Color fundus image, FOV: 45 degrees — 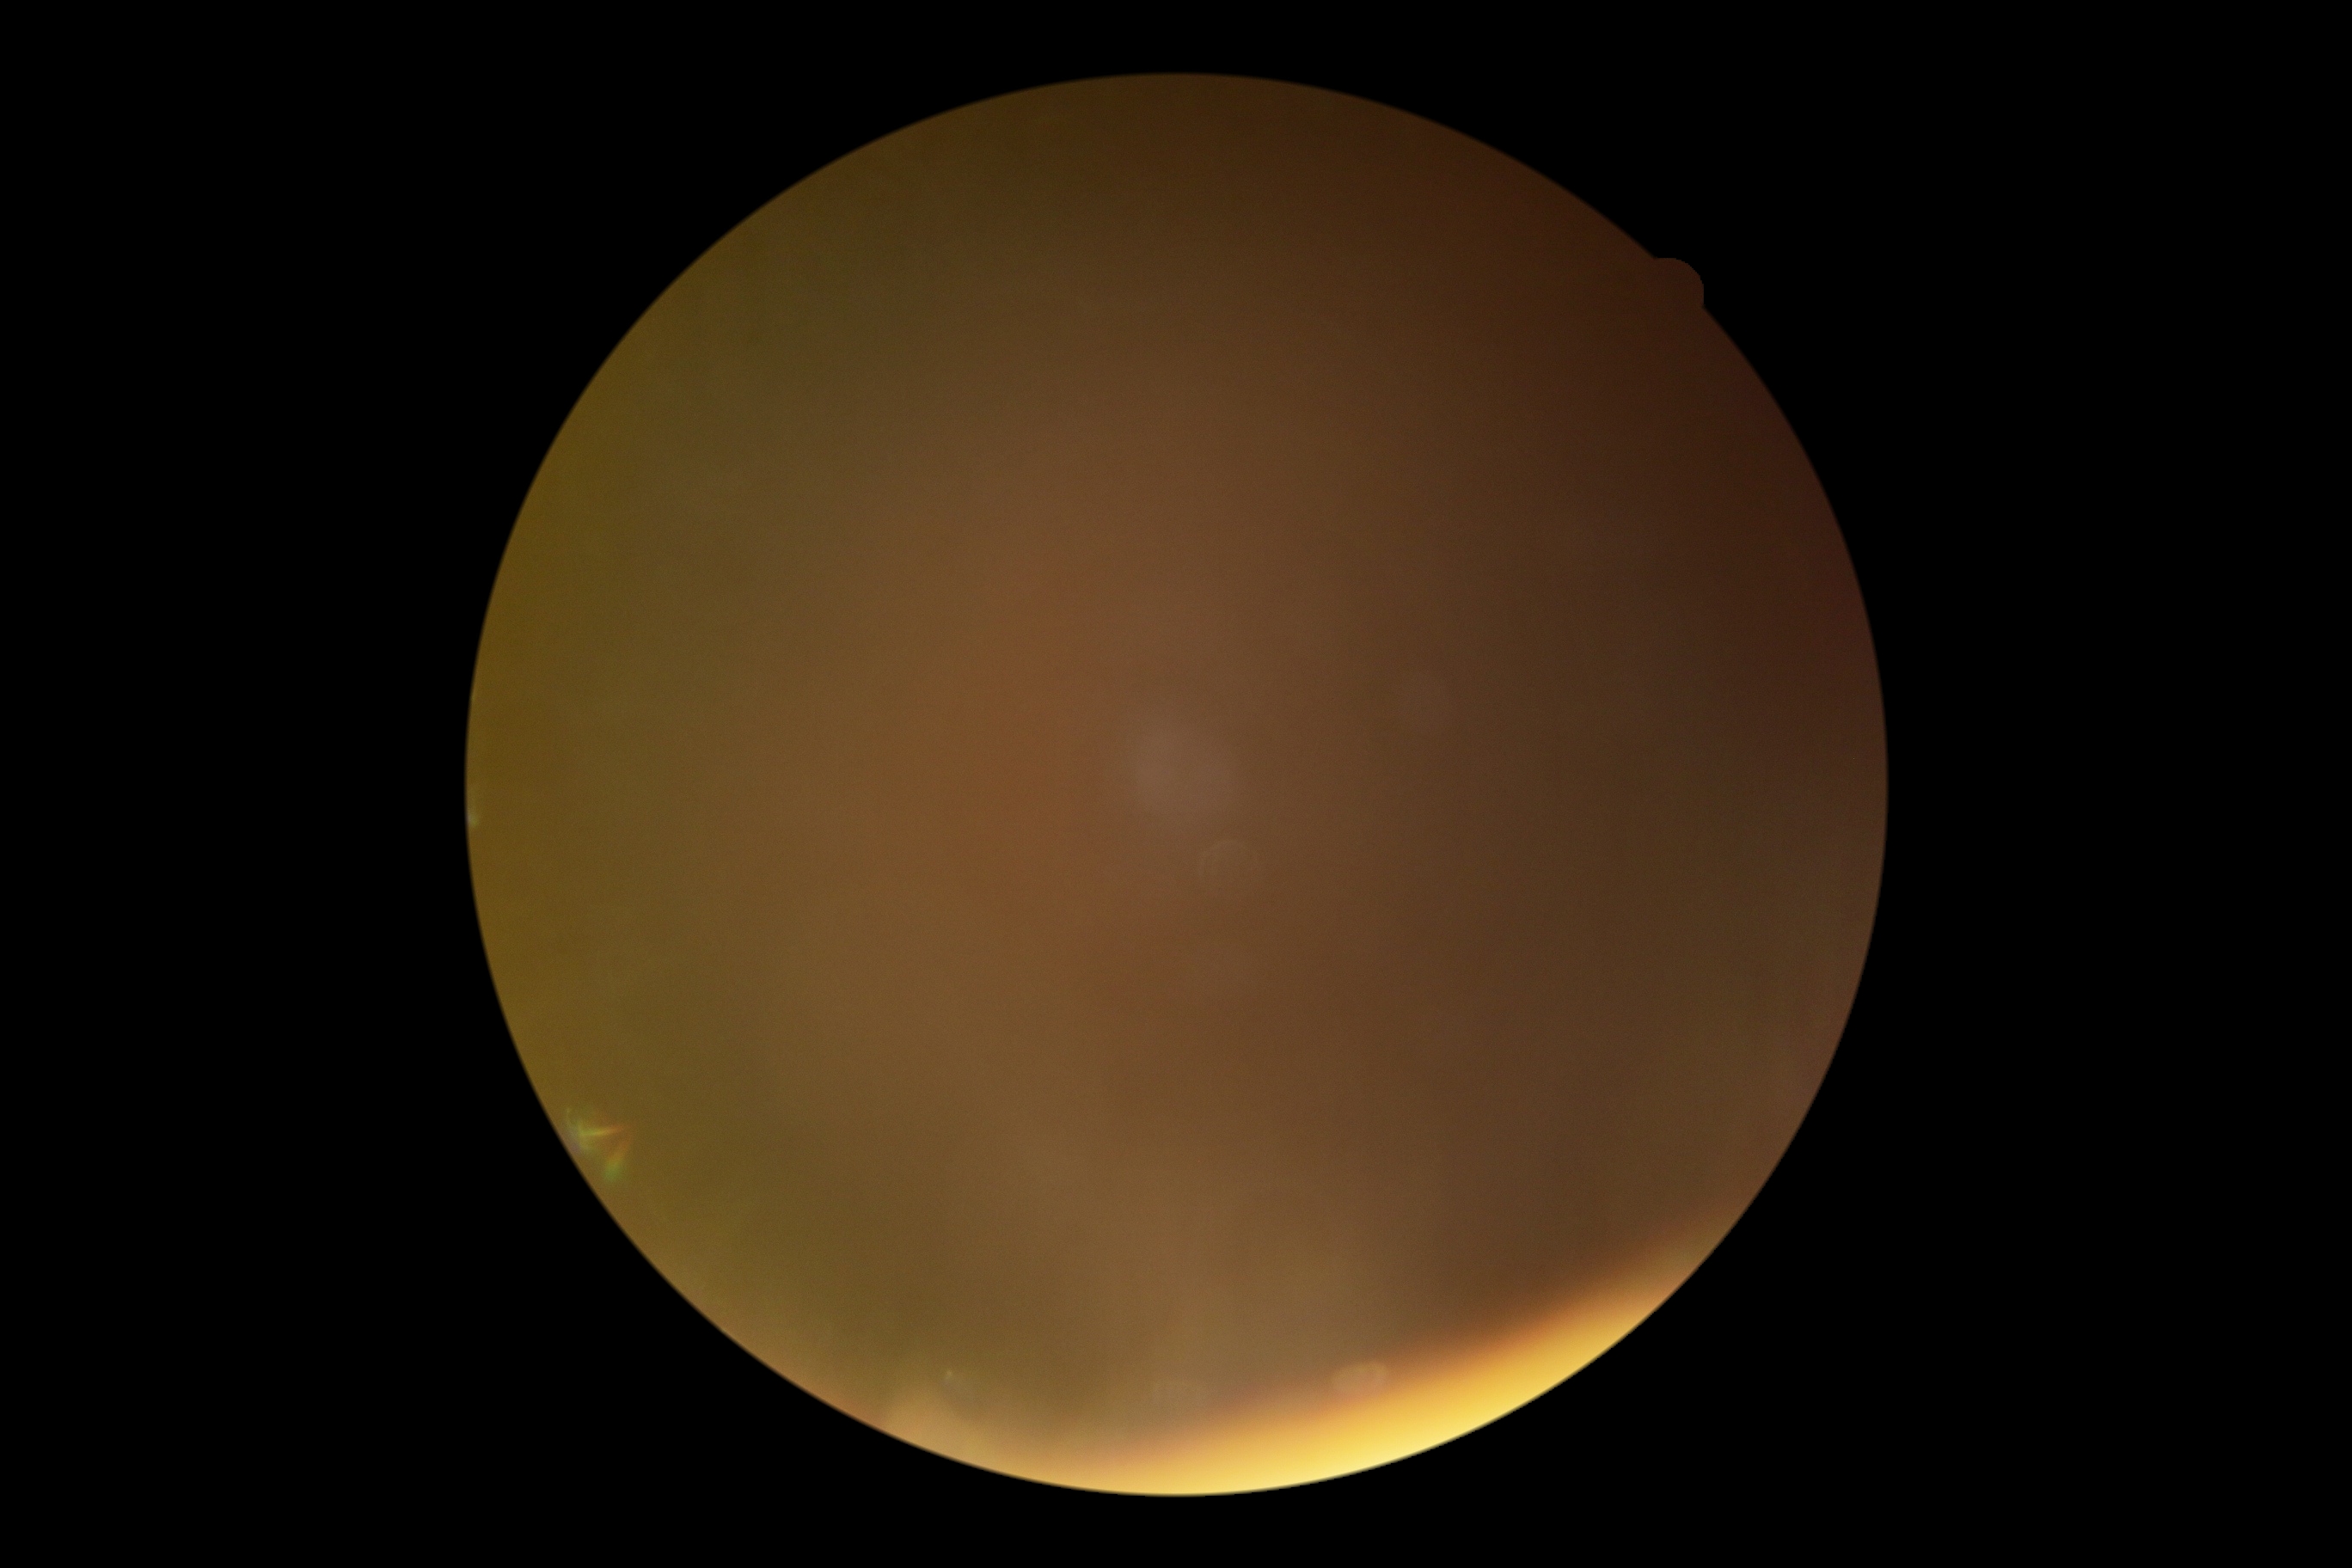
DR stage = ungradable
image quality = below grading threshold